848 x 848 pixels · nonmydriatic fundus photograph · NIDEK AFC-230 · 45° field of view
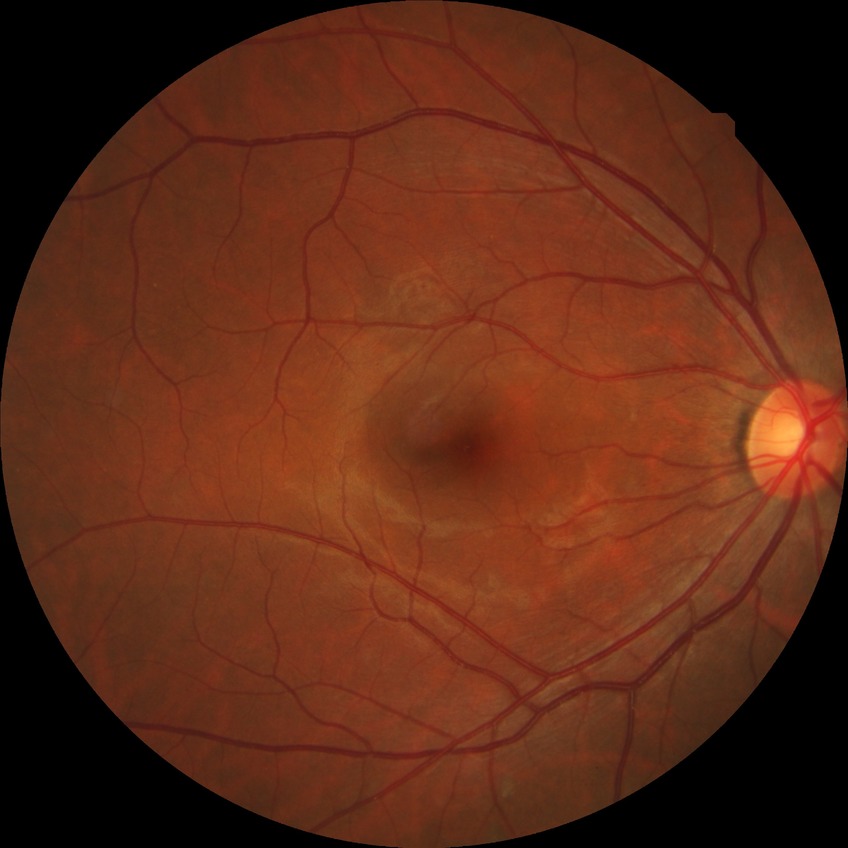
Diabetic retinopathy (DR): SDR (simple diabetic retinopathy).